45° FOV — 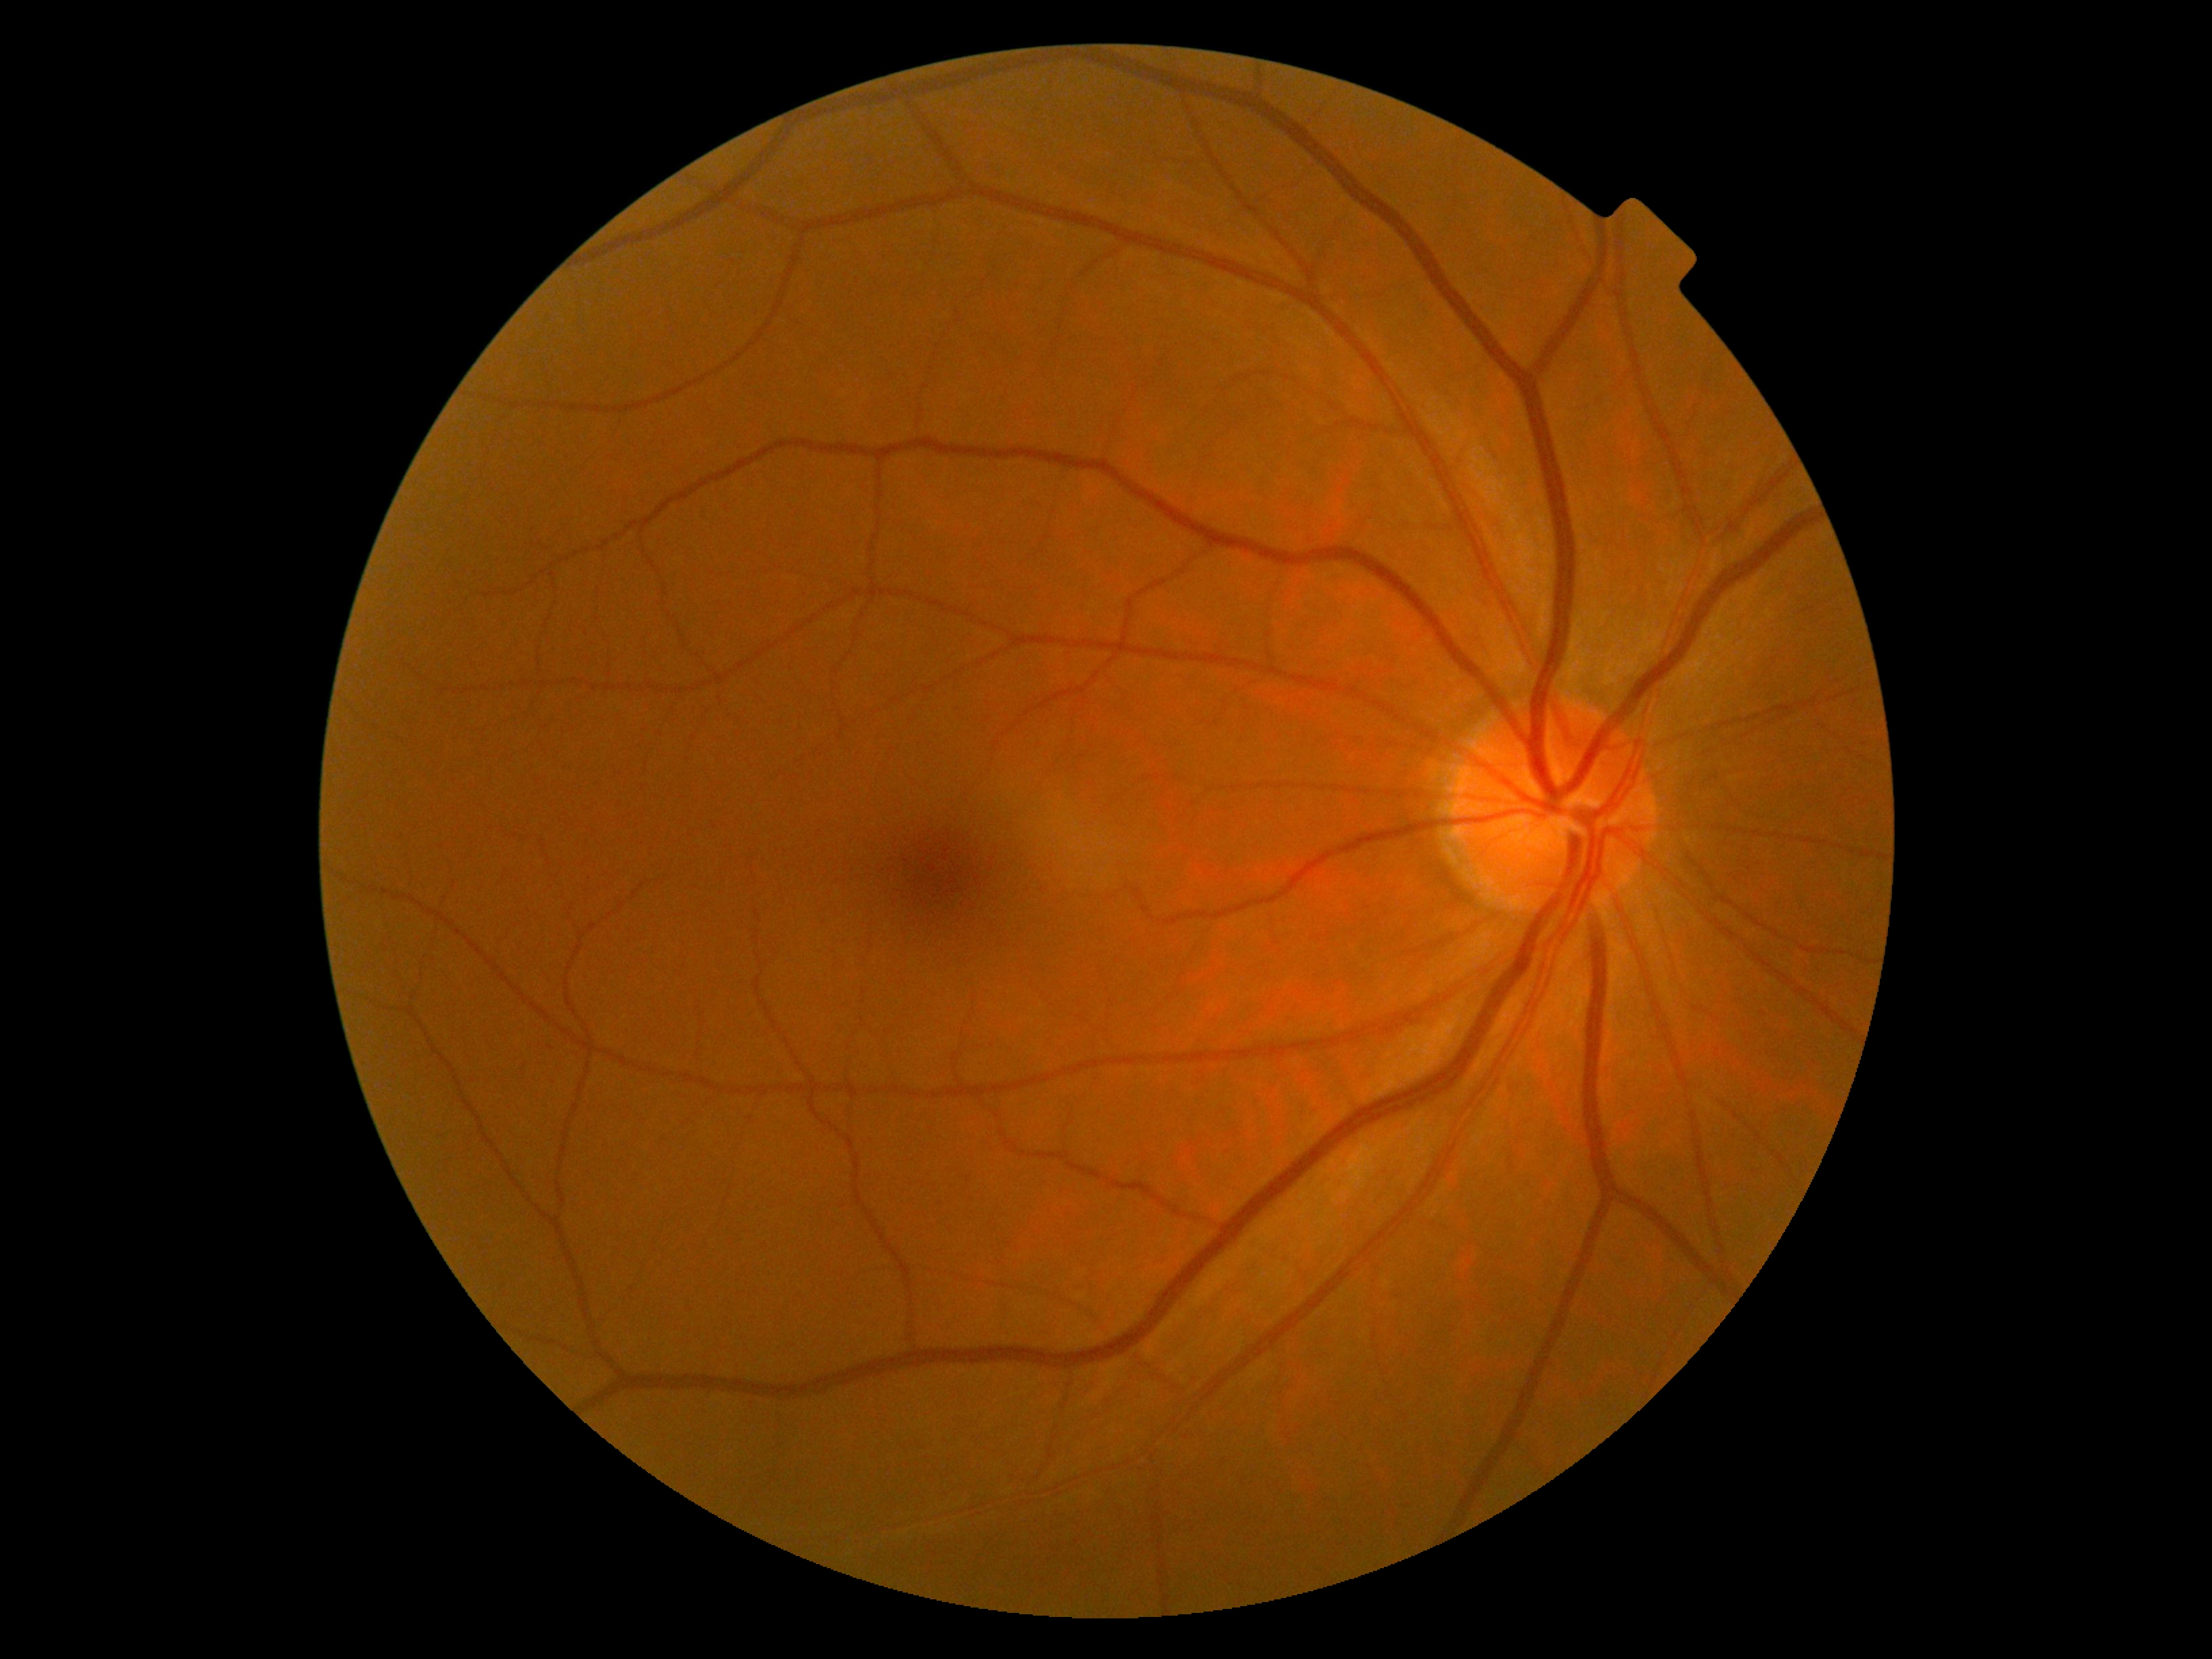

No apparent diabetic retinopathy.
Diabetic retinopathy (DR) is no apparent diabetic retinopathy (grade 0).